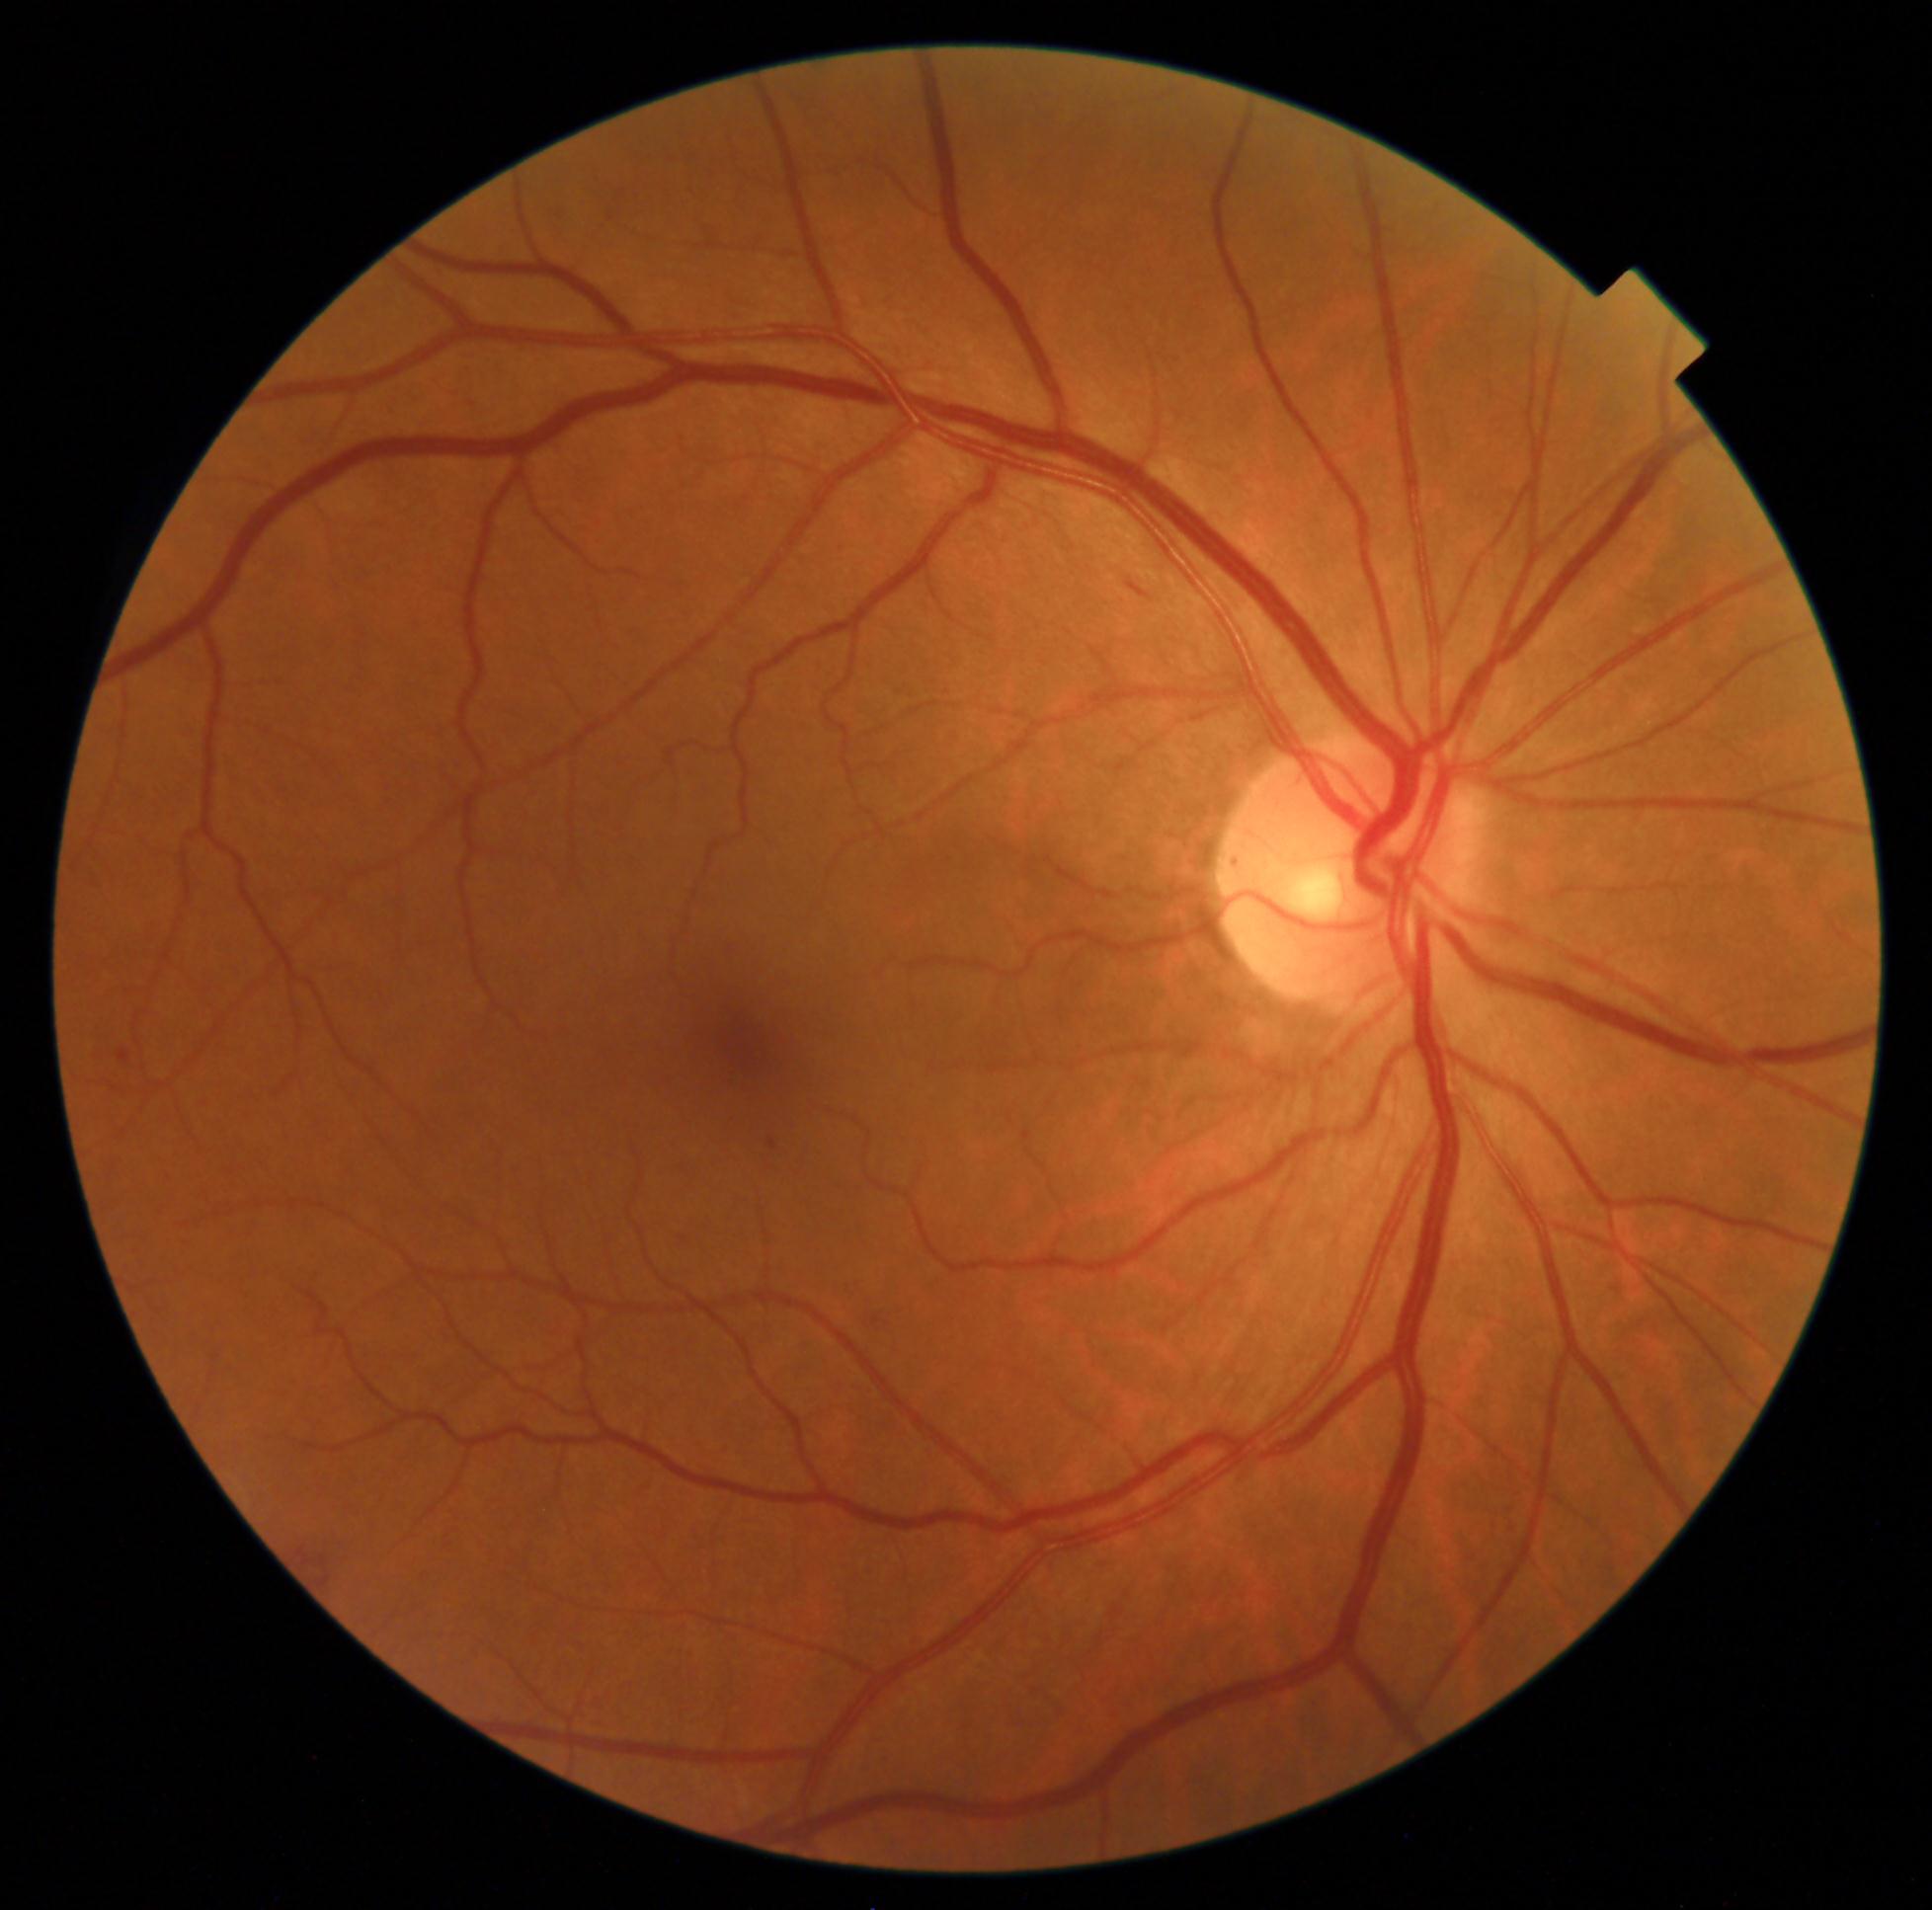

Diabetic retinopathy (DR): 2.
The retinopathy is classified as non-proliferative diabetic retinopathy.